45 degree fundus photograph.
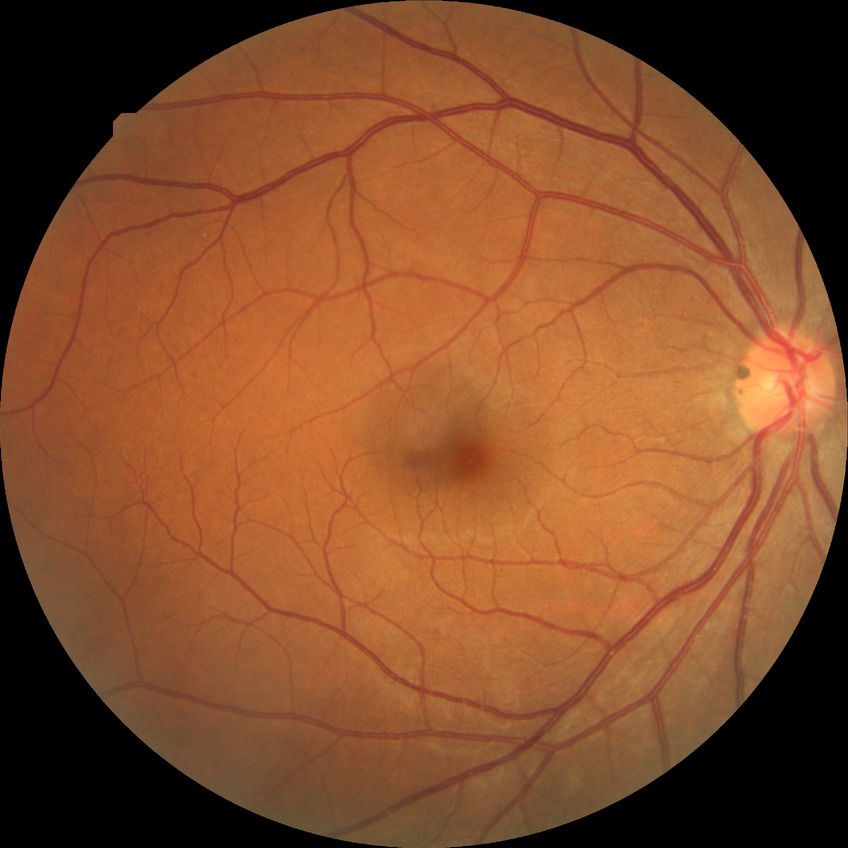
Diabetic retinopathy (DR): NDR (no diabetic retinopathy).